Remidio smartphone fundus camera:
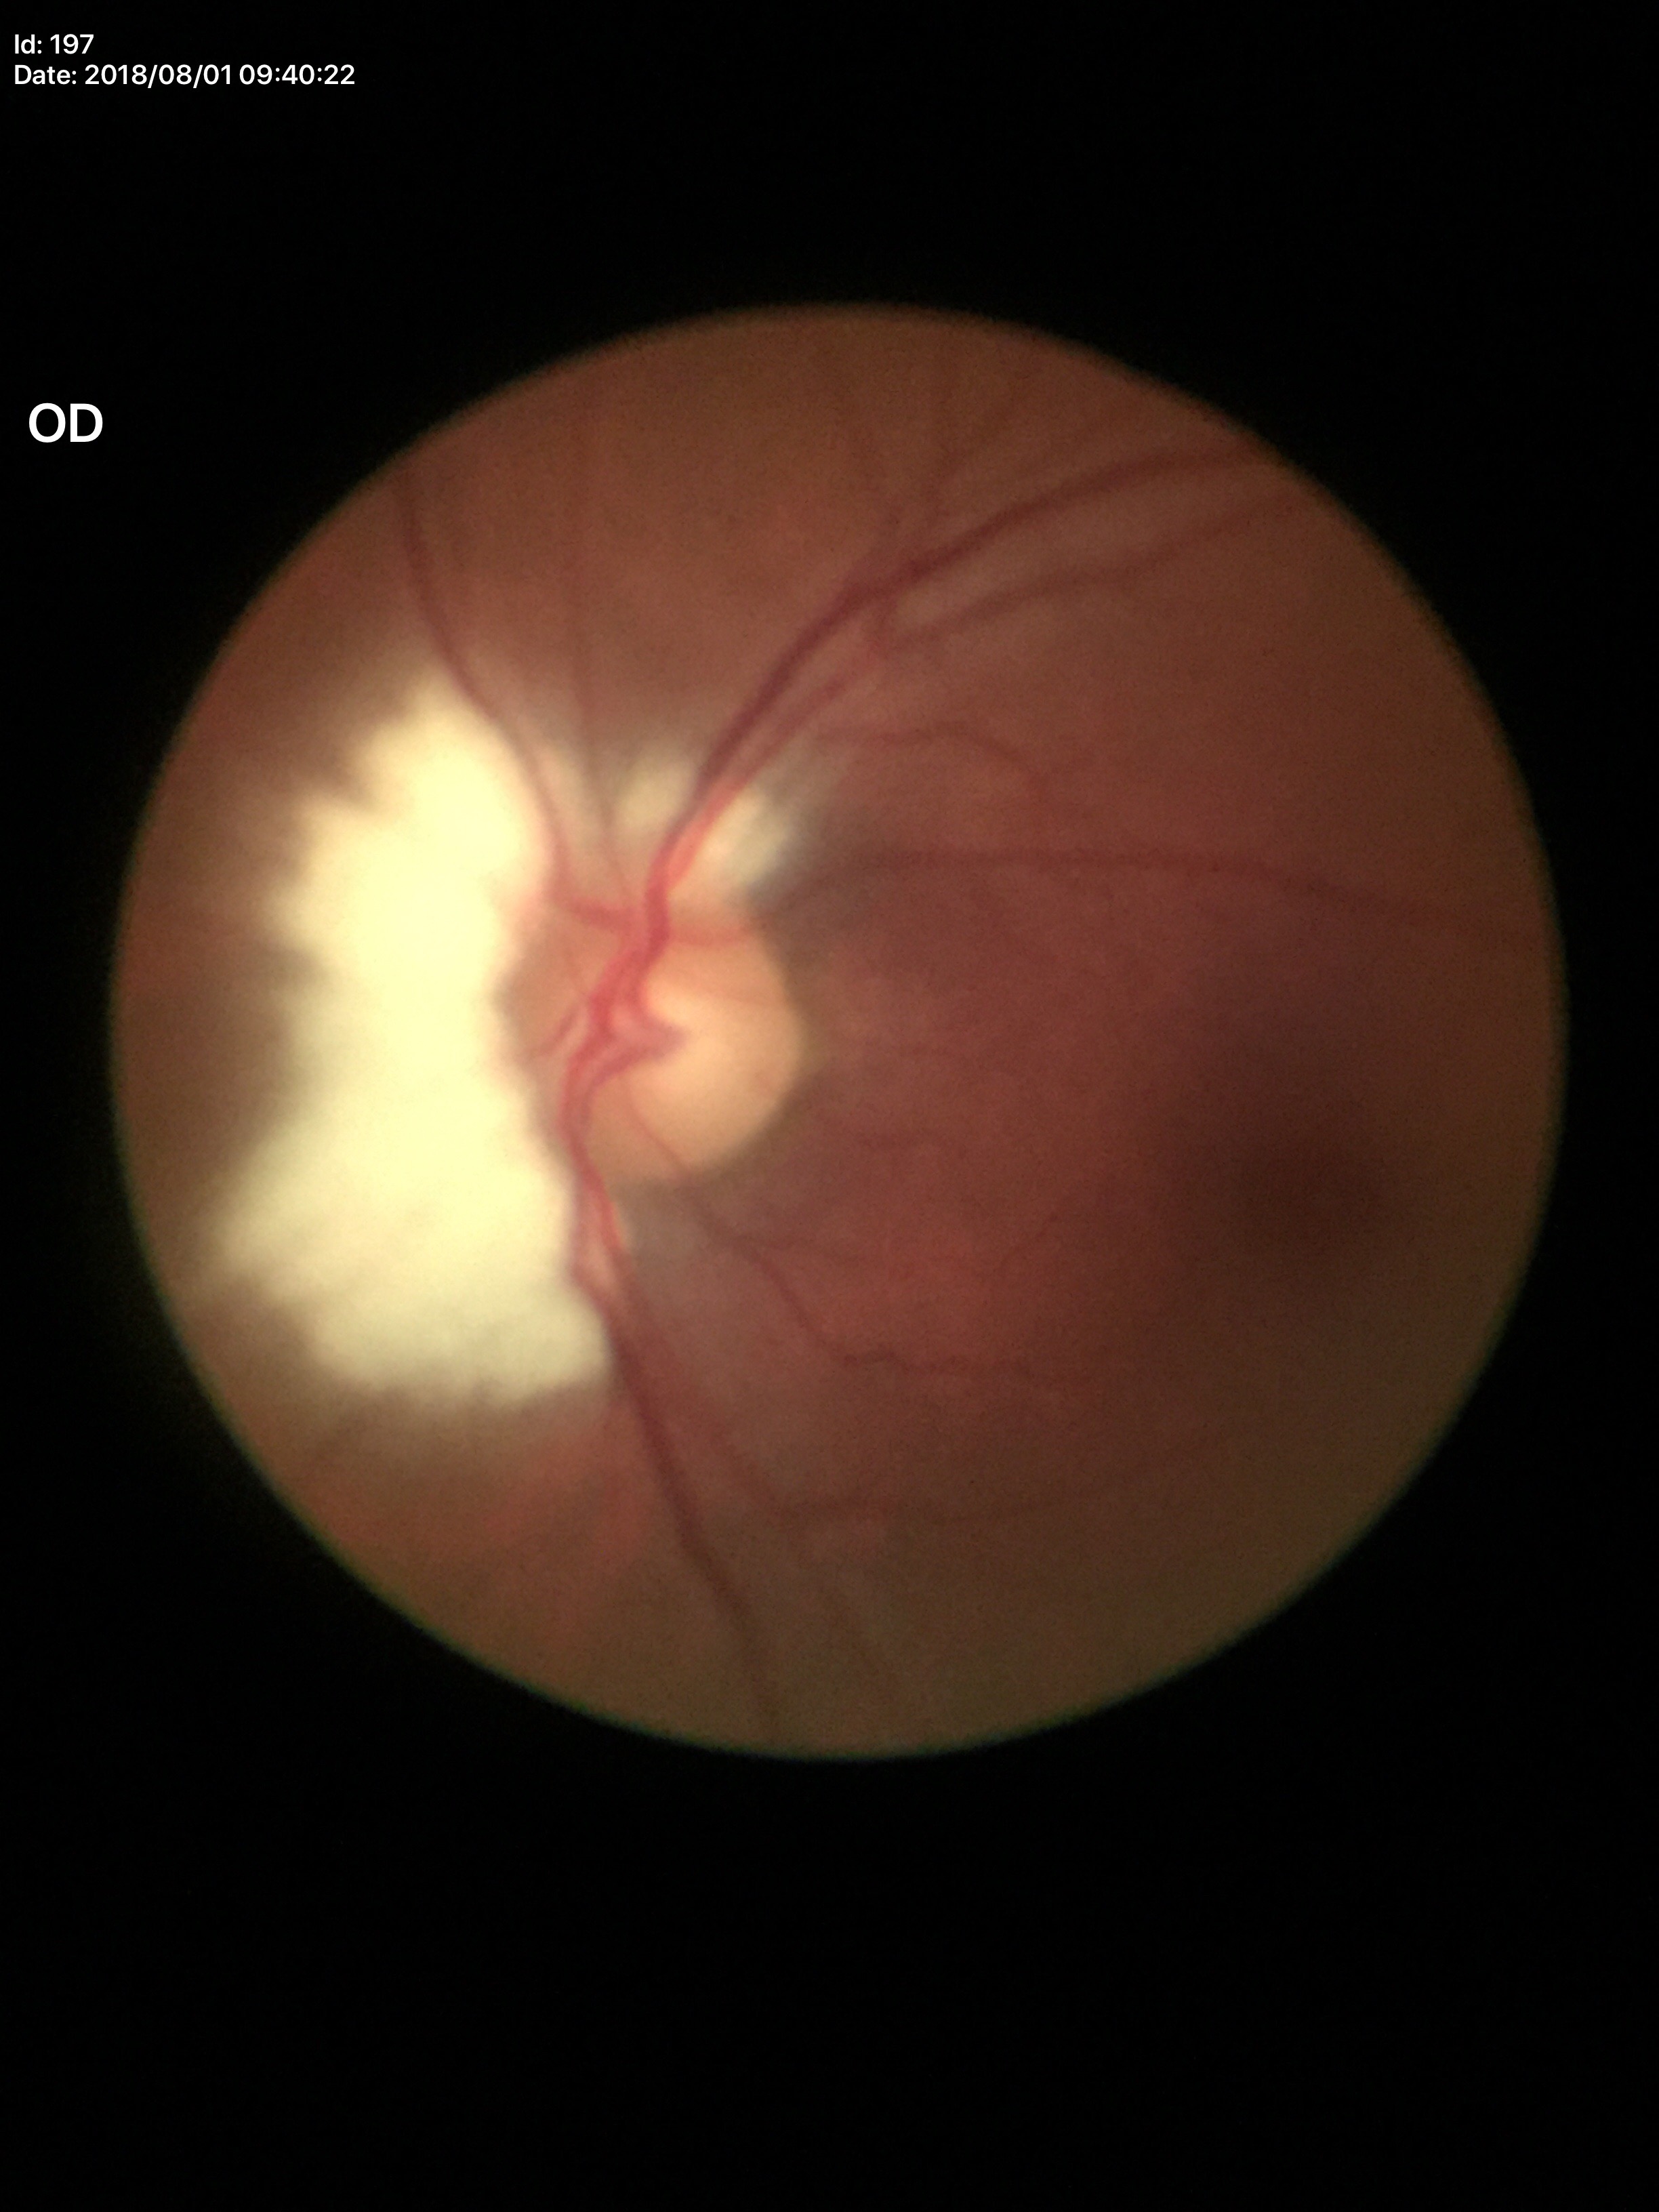

No evidence of glaucoma.
Vertical CDR: 0.49.
Area C/D ratio: 0.24.